45-degree field of view.
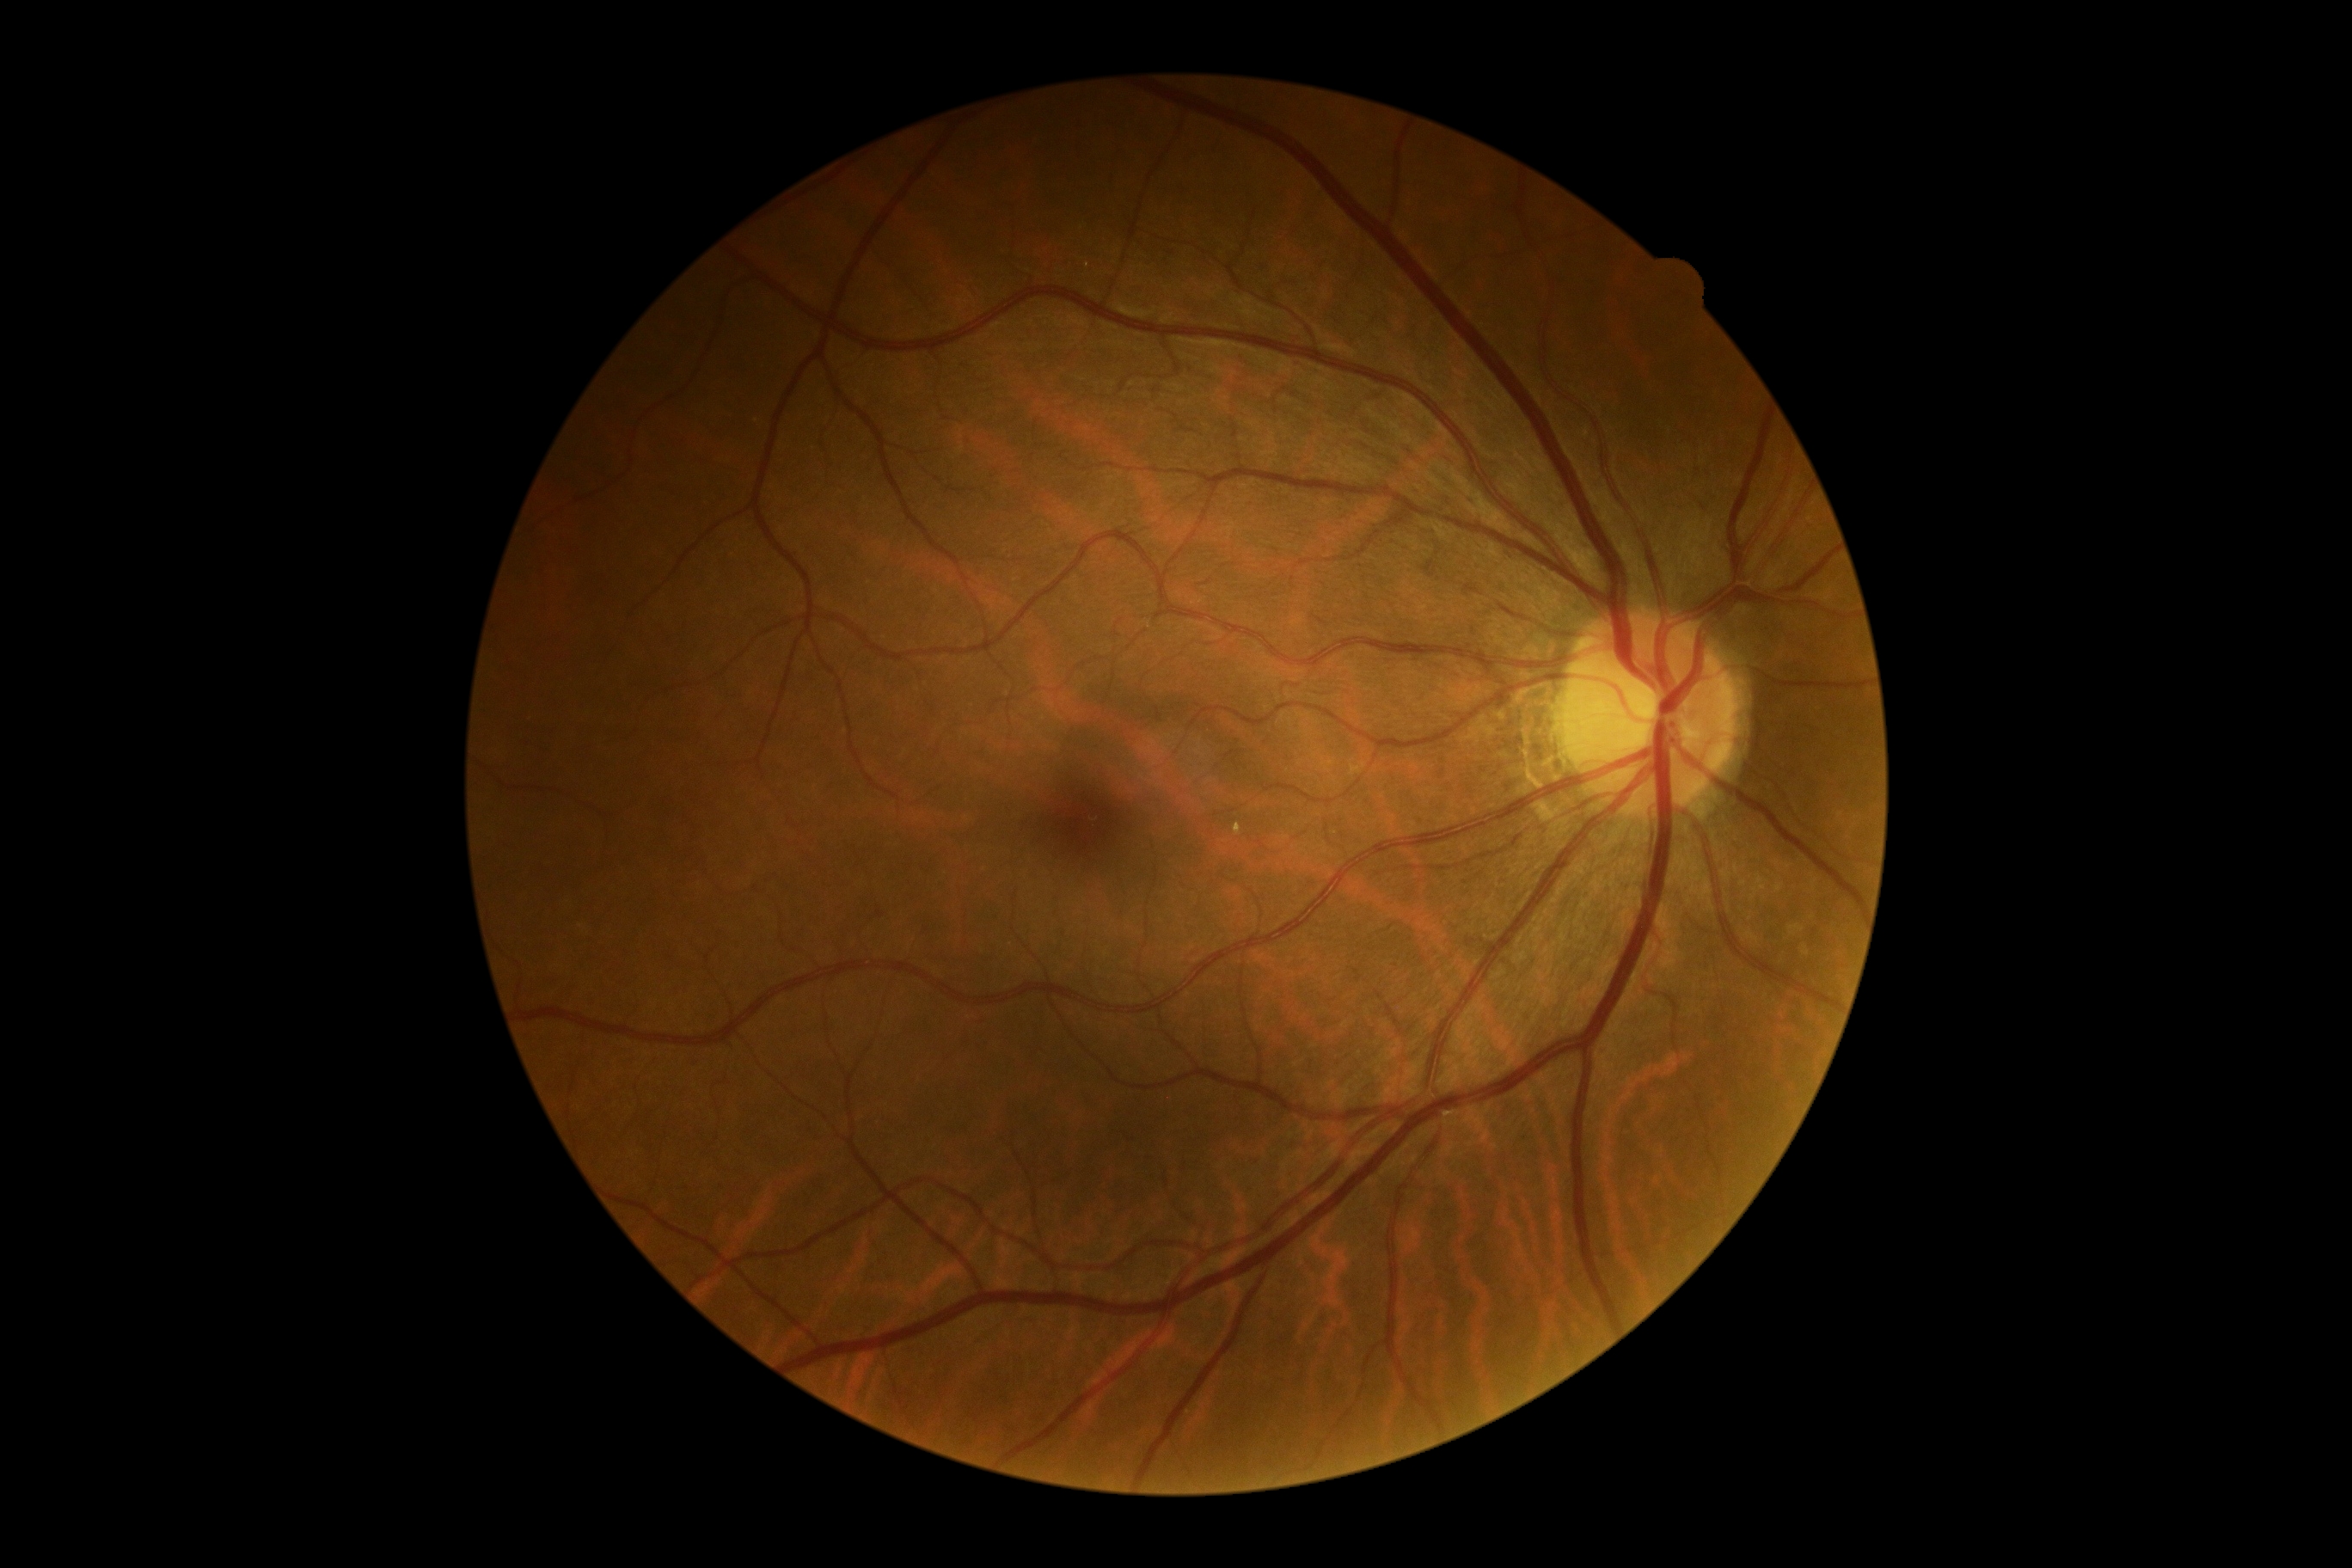

Retinopathy grade is 0 — no visible signs of diabetic retinopathy. No diabetic retinal disease findings.